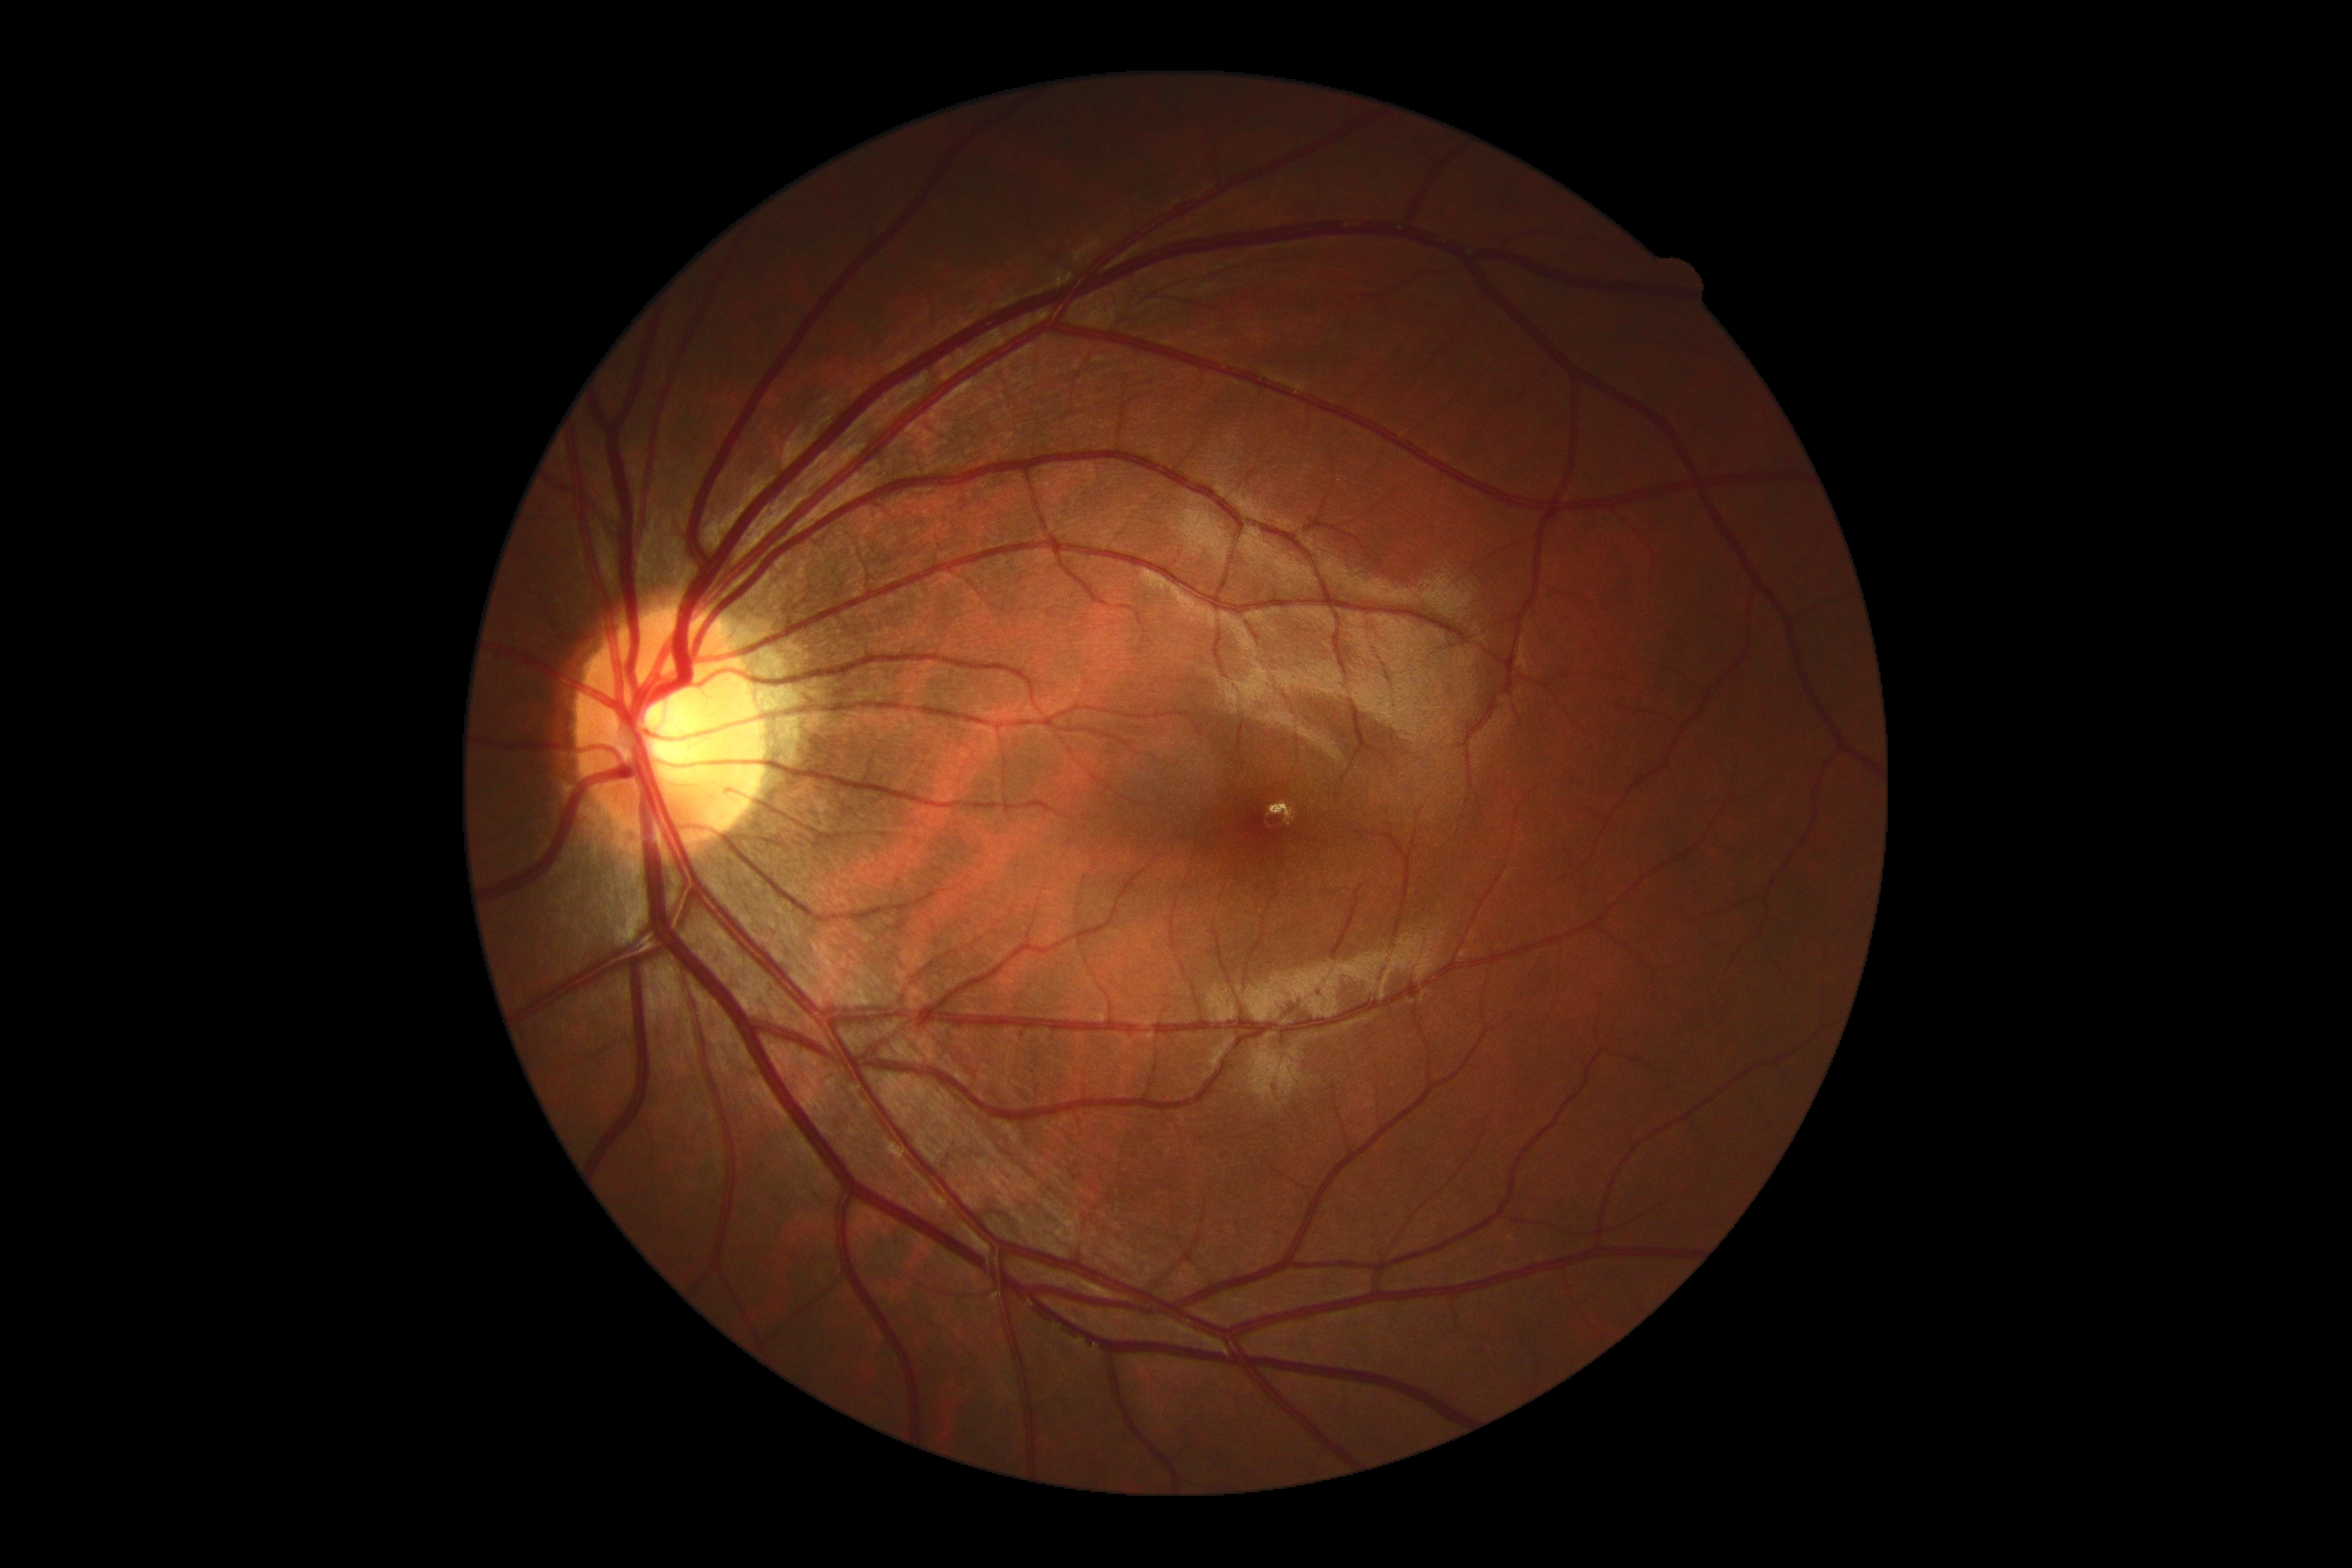
diabetic retinopathy (DR)=no apparent diabetic retinopathy (grade 0).